FOV: 45 degrees: 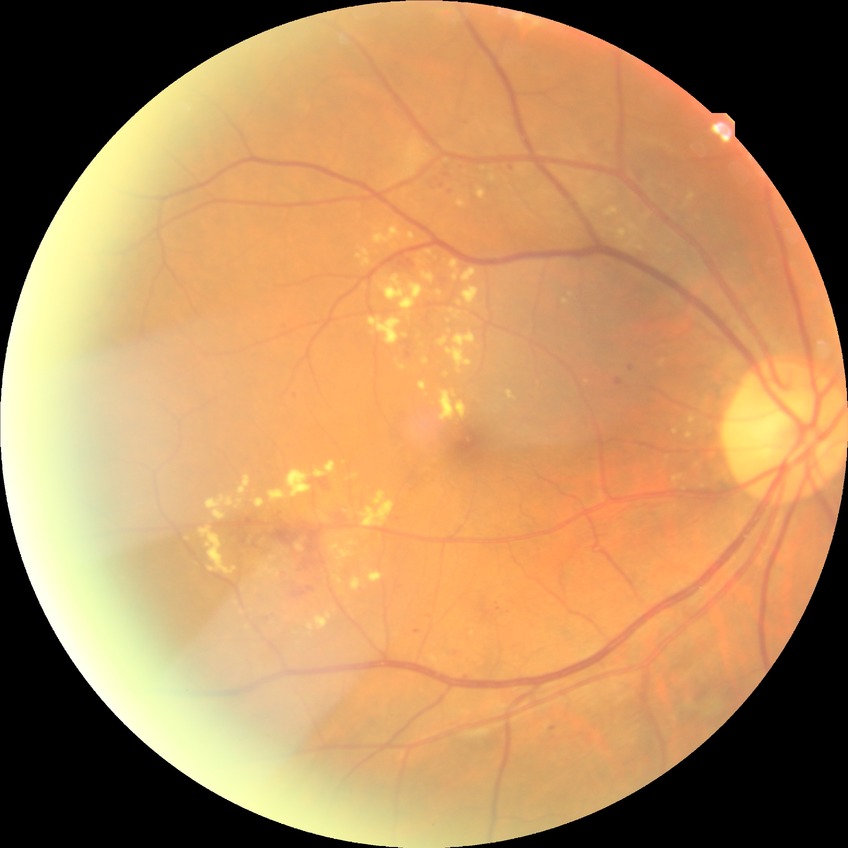
diabetic retinopathy (DR)@simple diabetic retinopathy (SDR).